Wide-field fundus photograph of an infant.
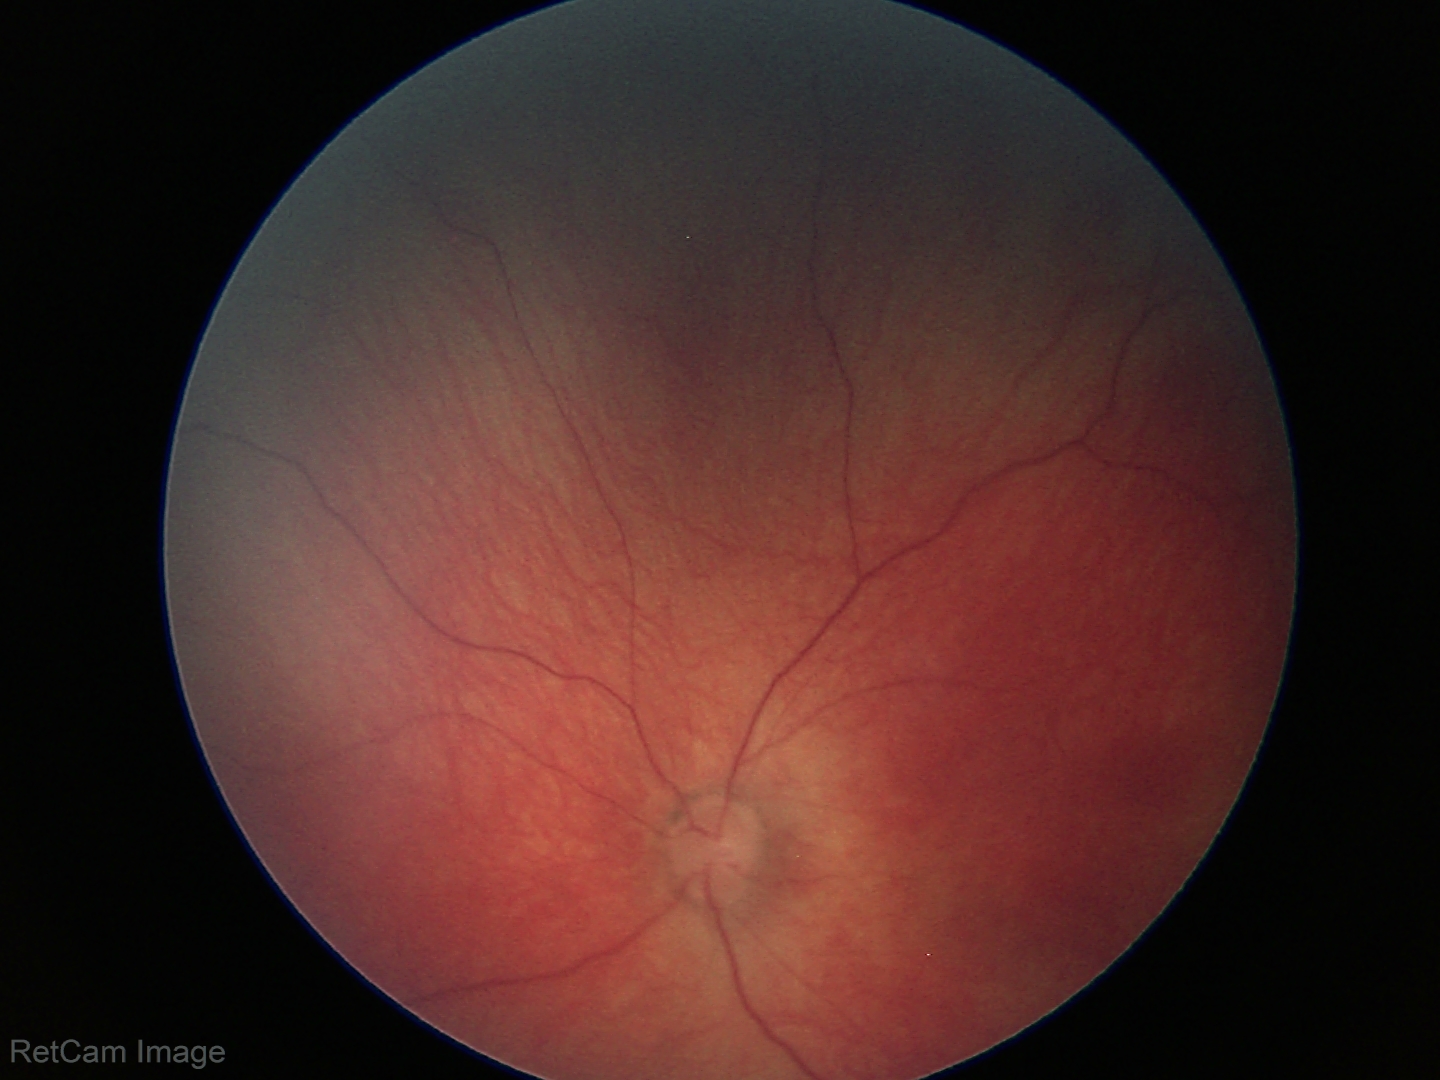
Normal screening examination.